1932x1932px.
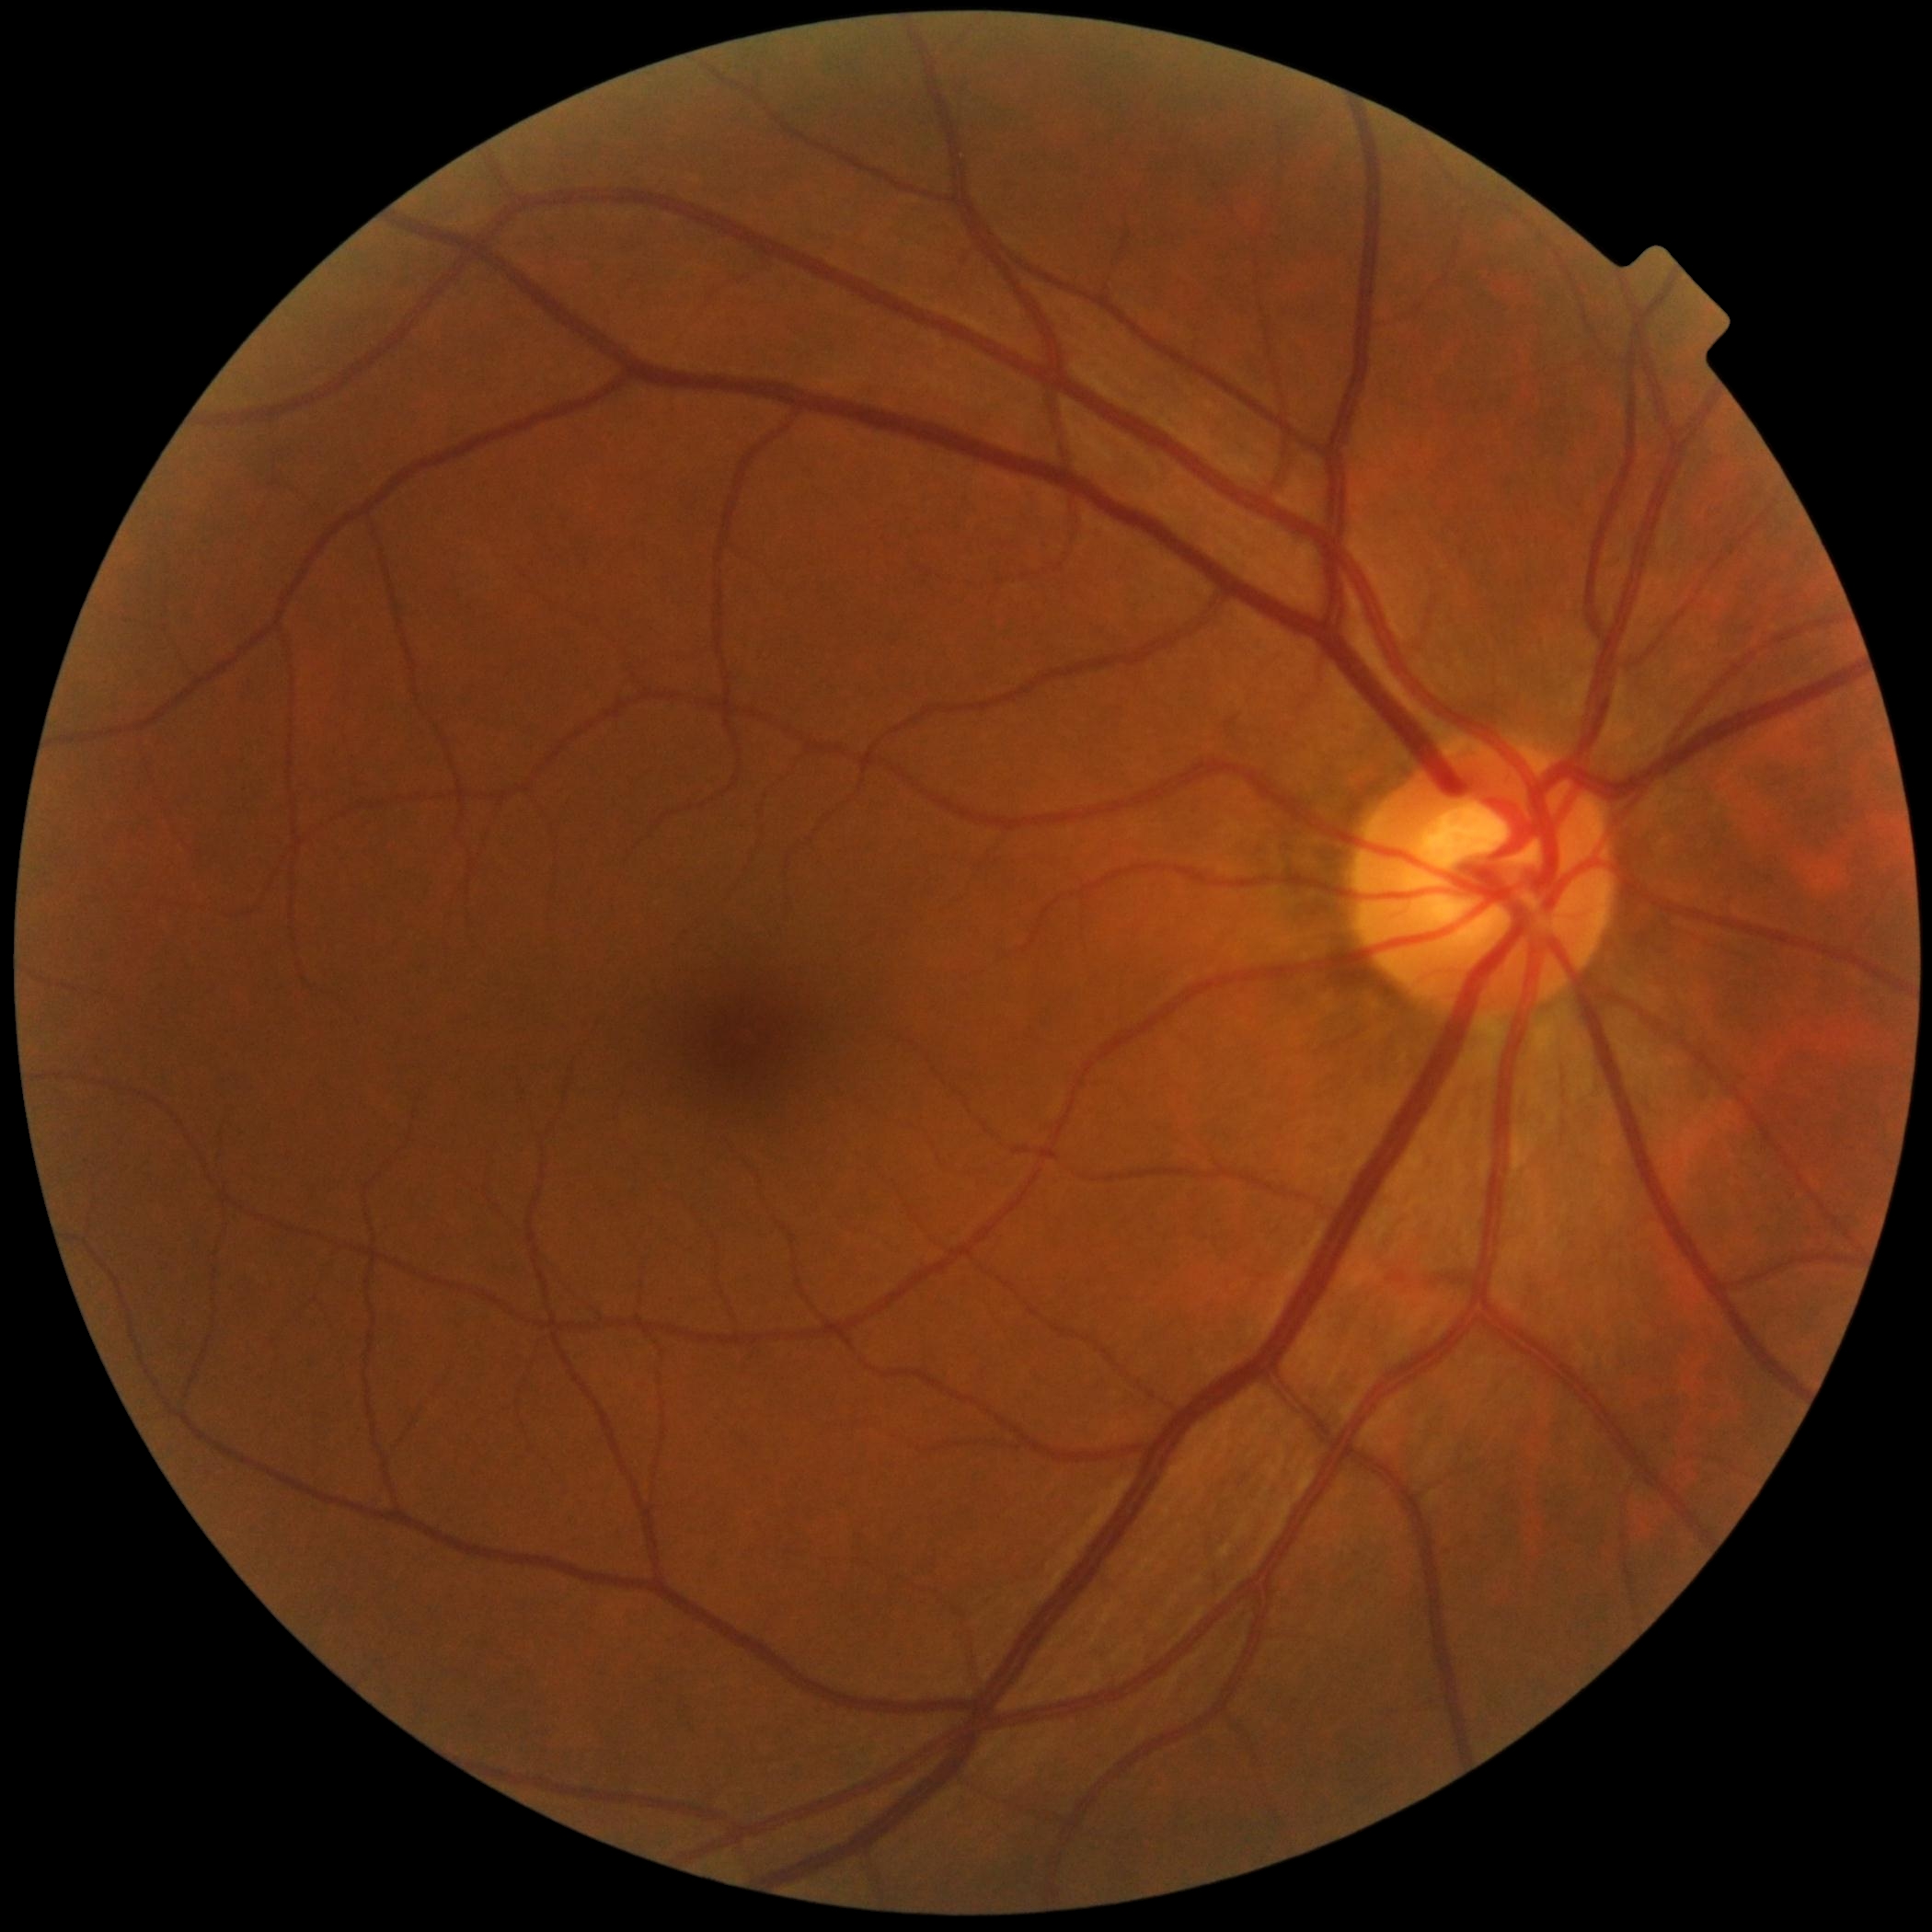
diabetic retinopathy grade: 0; DR impression: no DR findings.